2352 x 1568 pixels.
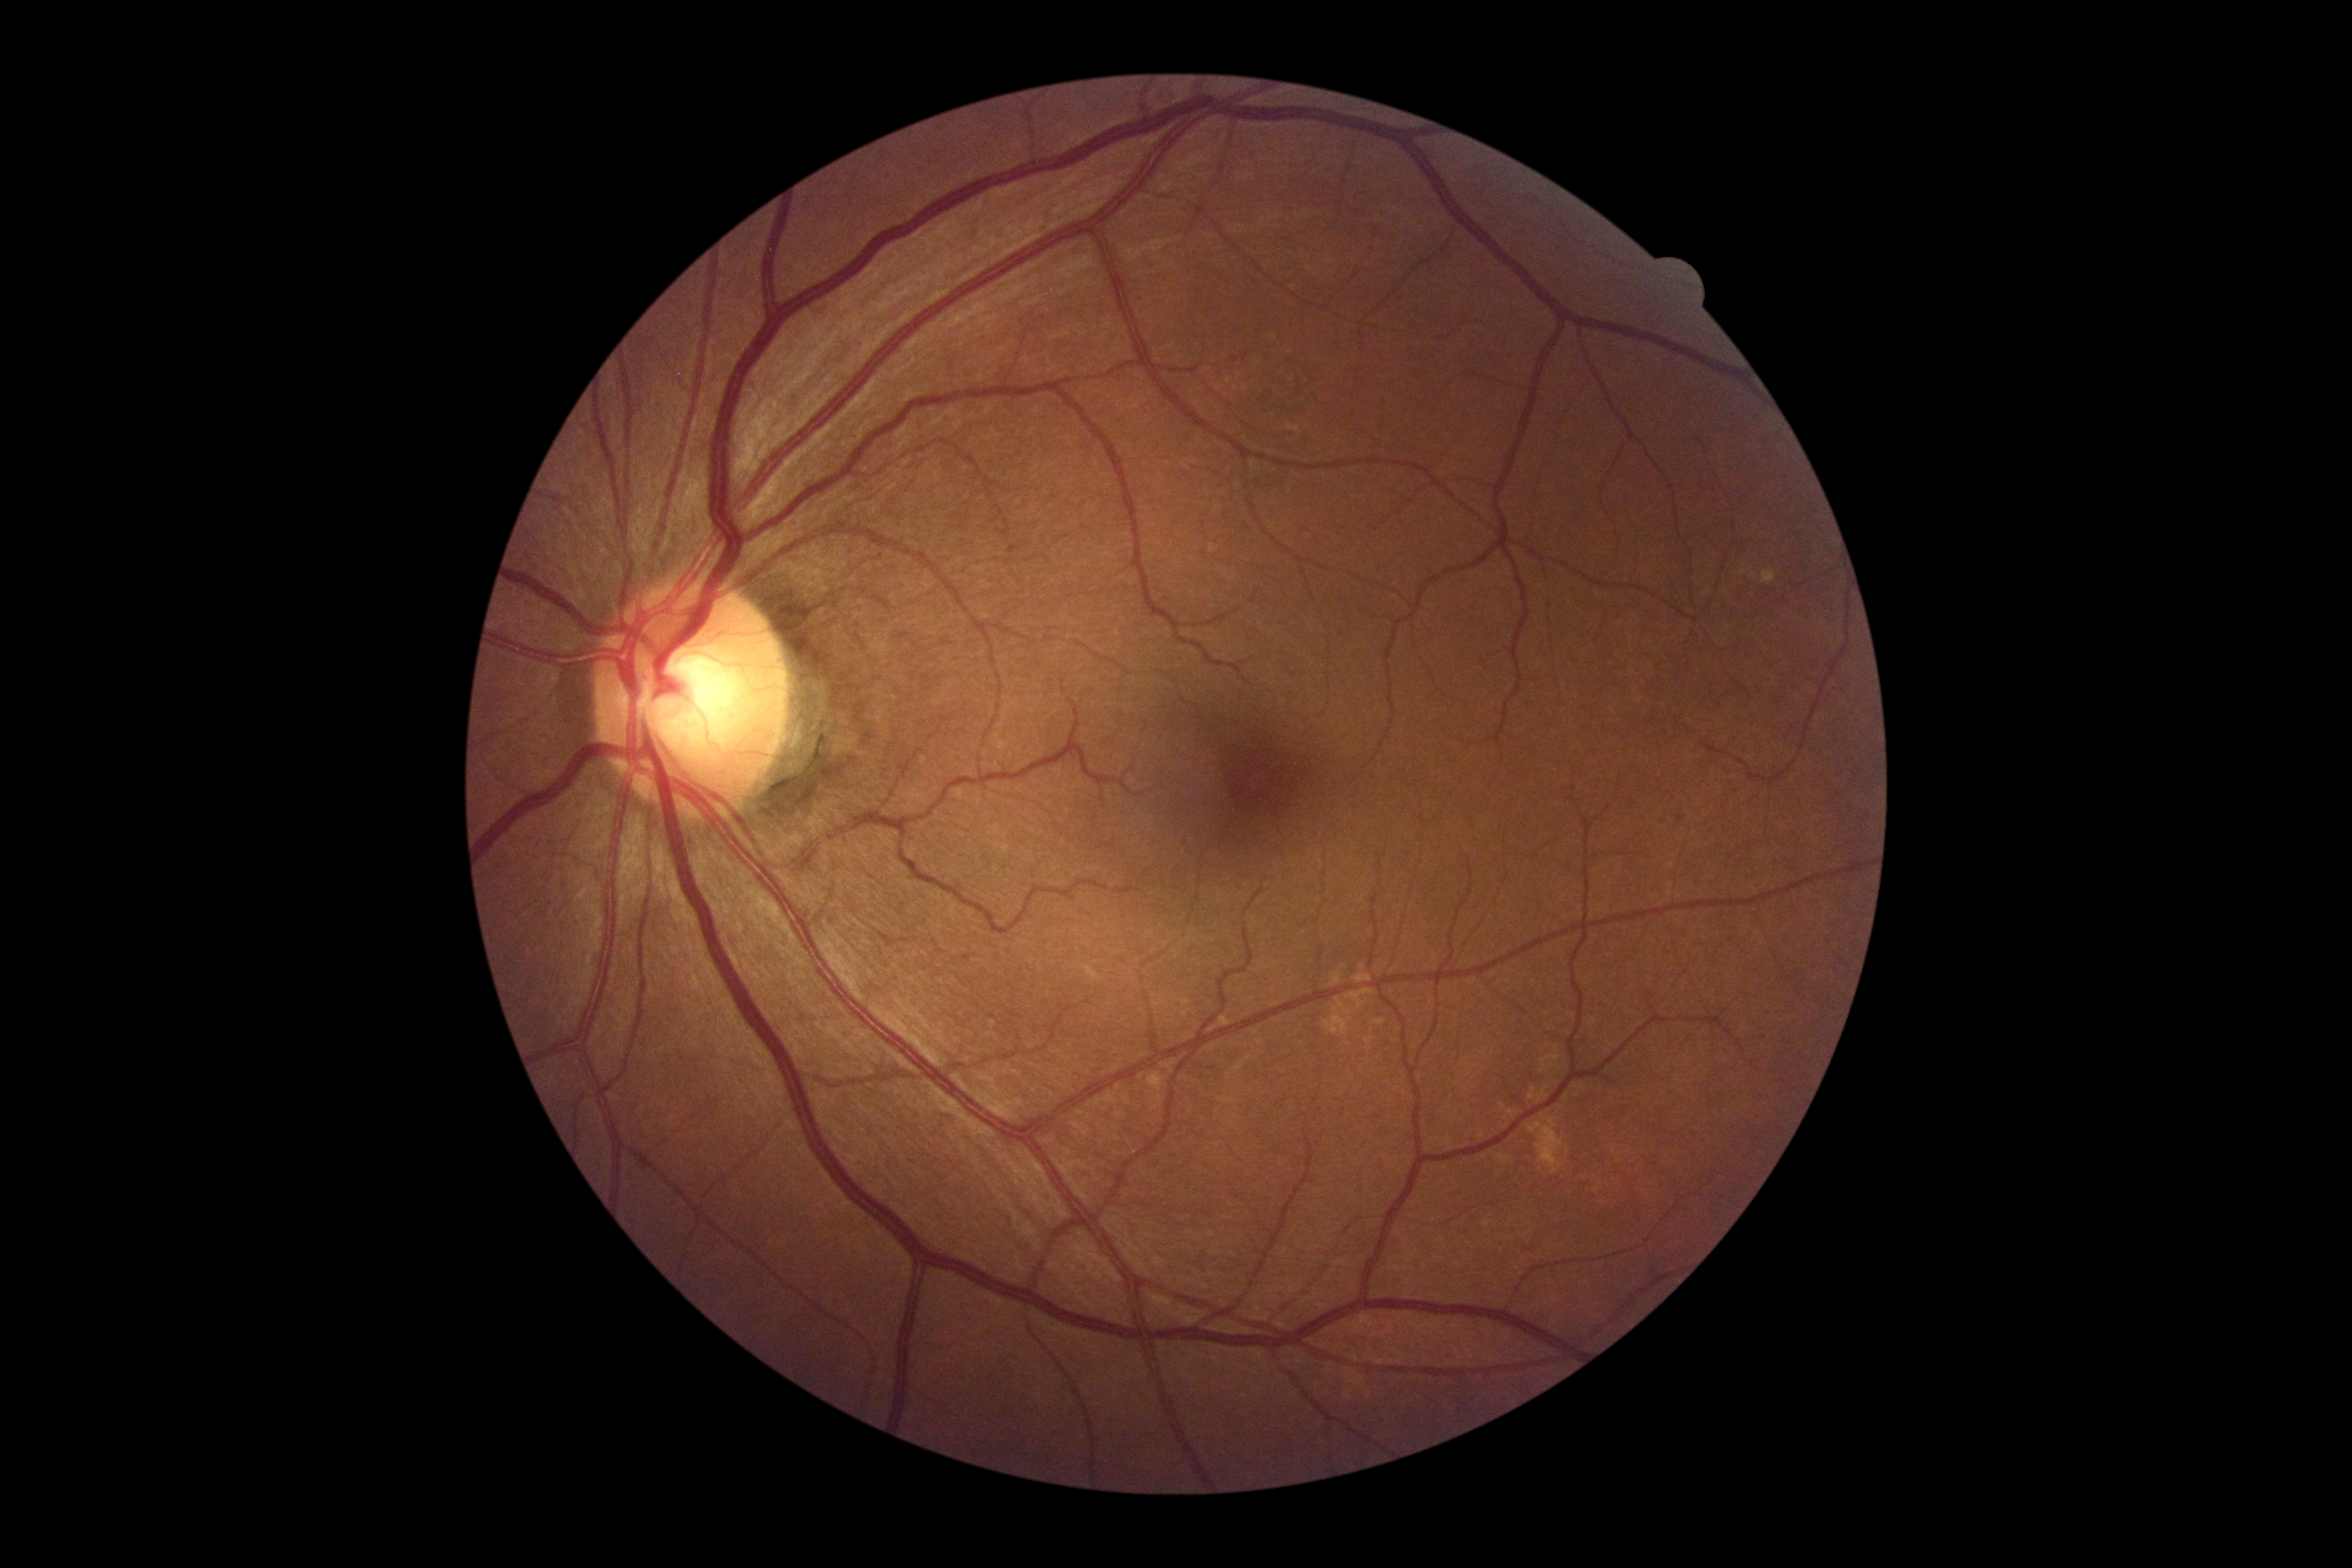
Diabetic retinopathy: grade 0 (no apparent retinopathy). No signs of diabetic retinopathy.